Wide-field fundus photograph from neonatal ROP screening: 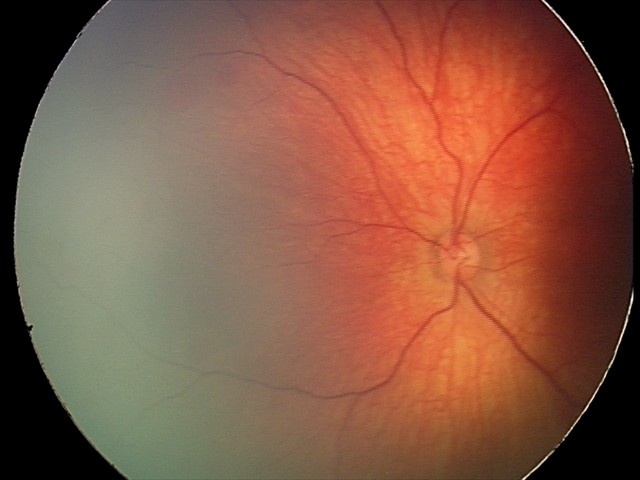
Diagnosis from this screening exam: retinal hemorrhages.